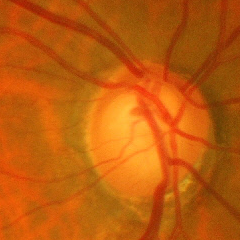
Q: What is the glaucoma diagnosis?
A: Severe glaucomatous damage.